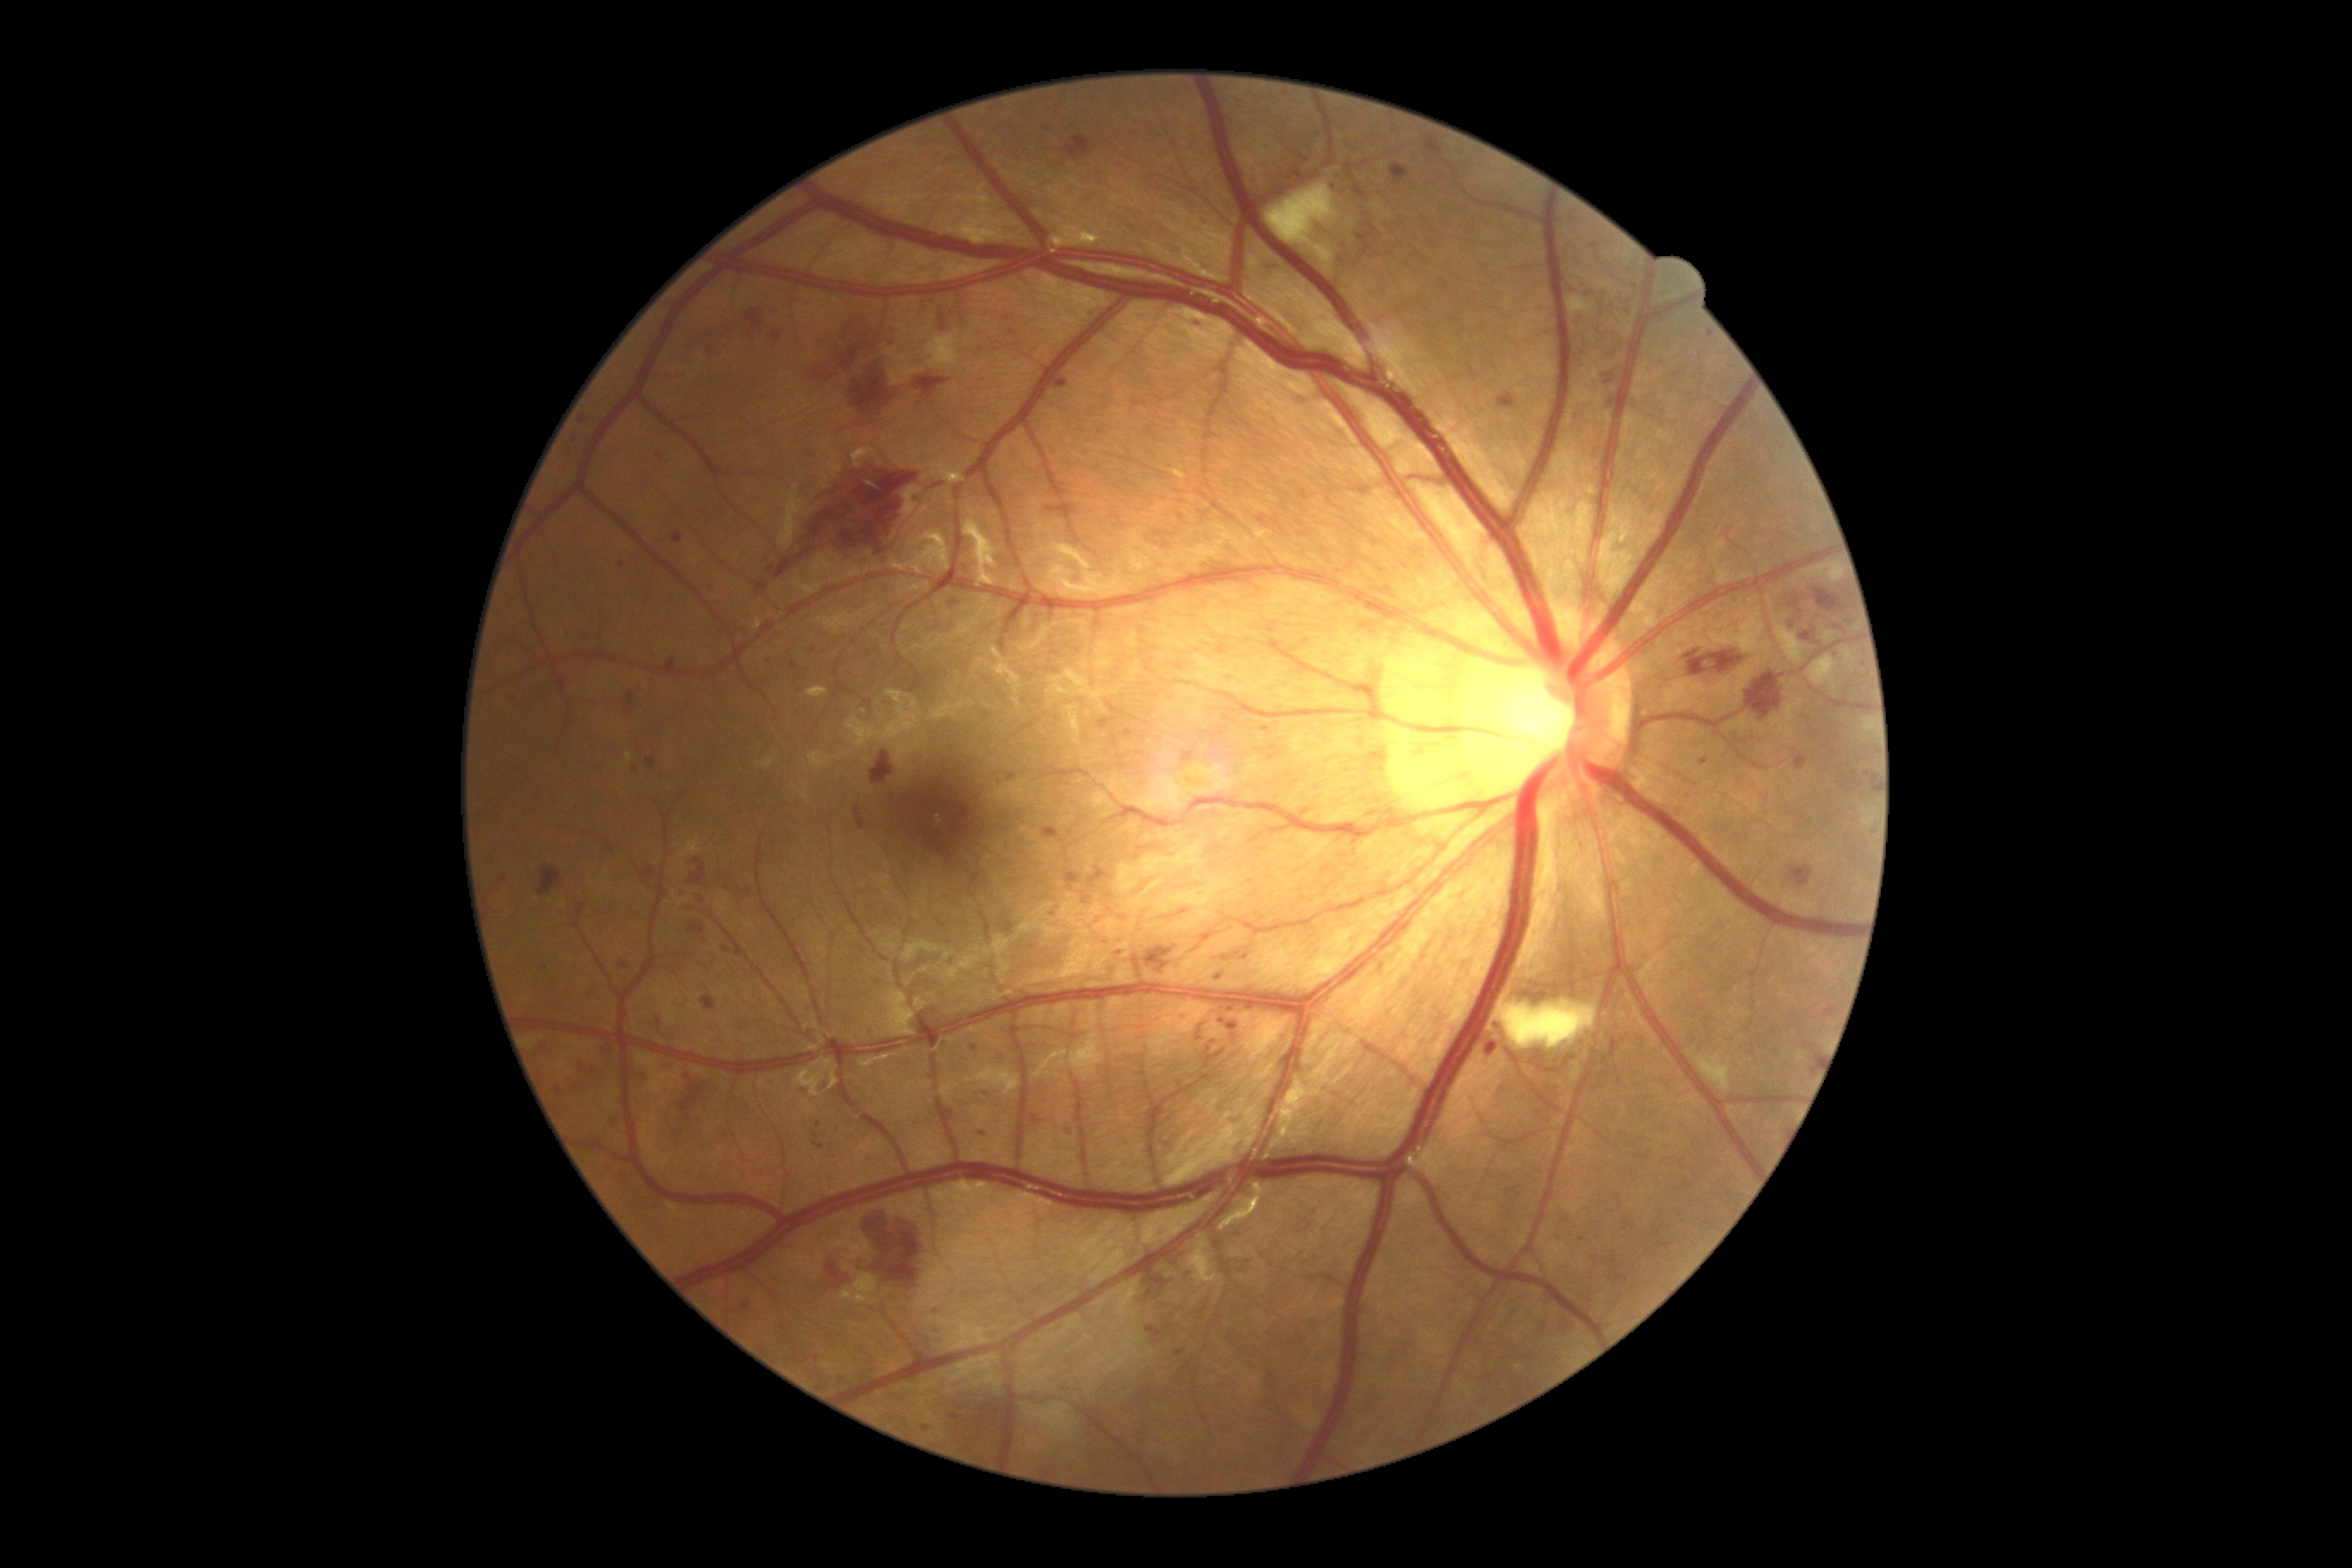 Diabetic retinopathy (DR): severe NPDR (grade 3)
Lesions identified (partial list):
hemorrhages (HEs) (subset) = rect(1144, 1270, 1179, 1309) | rect(852, 358, 891, 408) | rect(532, 1038, 548, 1057) | rect(747, 312, 763, 338) | rect(1799, 632, 1815, 642) | rect(916, 376, 950, 398) | rect(1789, 622, 1796, 630) | rect(1789, 599, 1804, 615) | rect(1043, 828, 1060, 840) | rect(1467, 365, 1479, 381) | rect(579, 1067, 597, 1075) | rect(689, 857, 706, 886) | rect(618, 962, 628, 969) | rect(537, 867, 561, 897) | rect(1089, 869, 1108, 886) | rect(639, 1062, 646, 1082) | rect(1844, 778, 1858, 787)
Small HEs approximately at <pt>710,350</pt> | <pt>800,198</pt> | <pt>896,329</pt>